Infant wide-field fundus photograph — 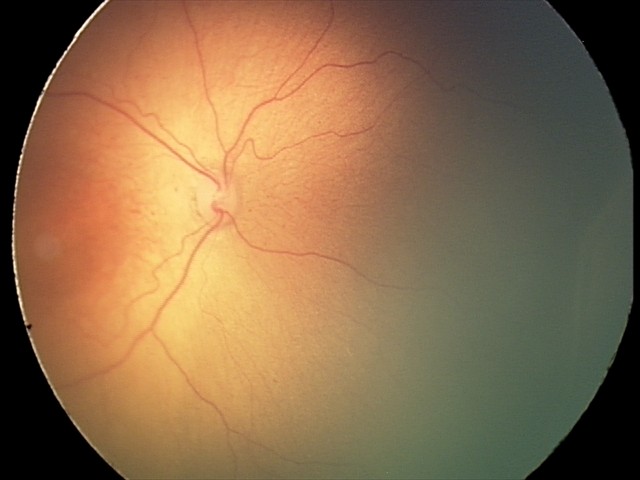
Assessment: ROP stage 2.